Macula-centered; color fundus photograph; image size 1932x1932
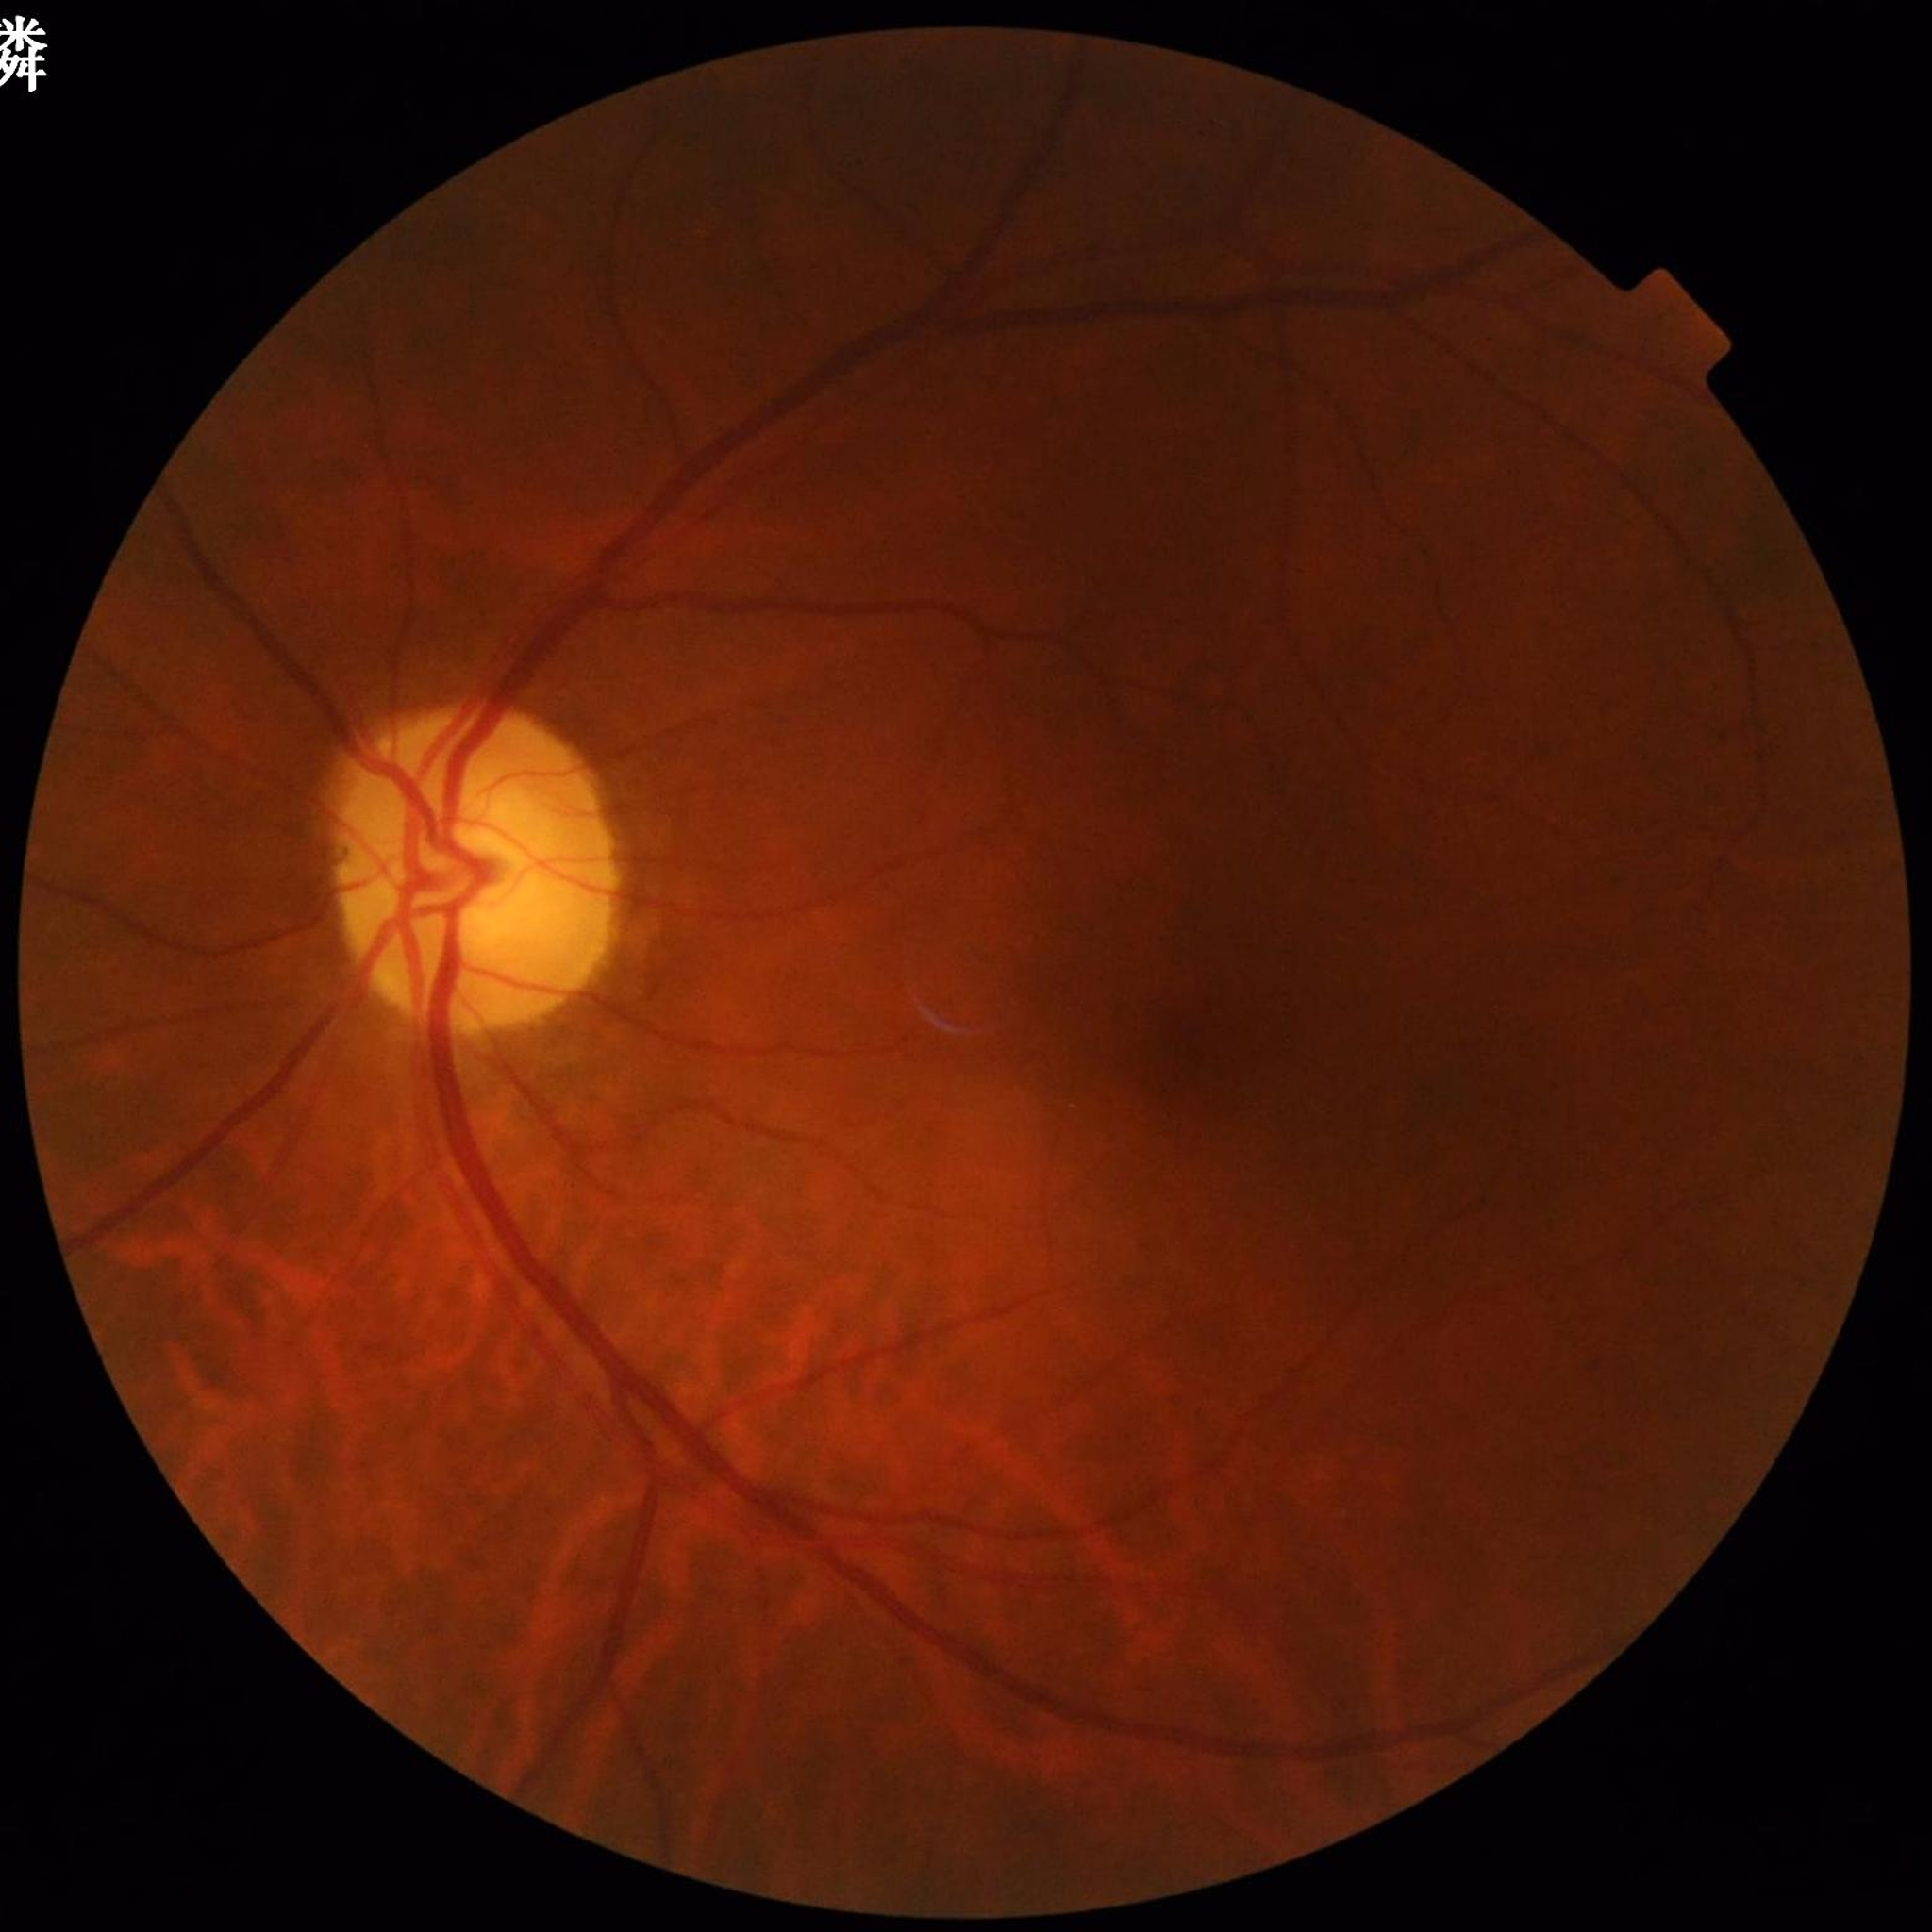
diagnosis: glaucoma